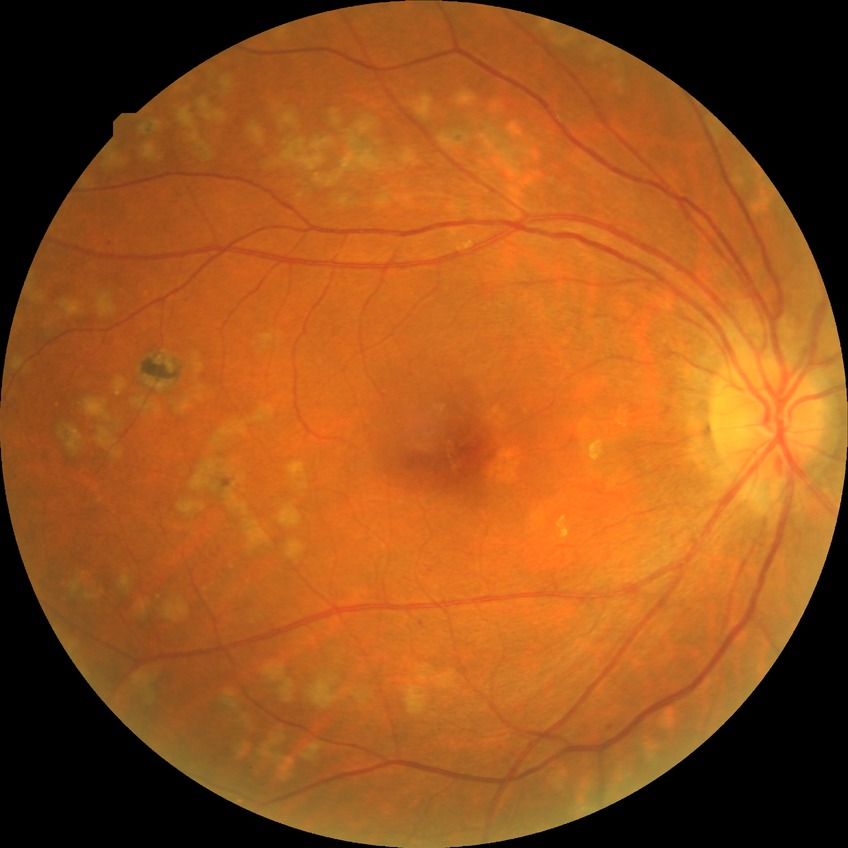 Davis DR grade: PDR.